Color fundus image:
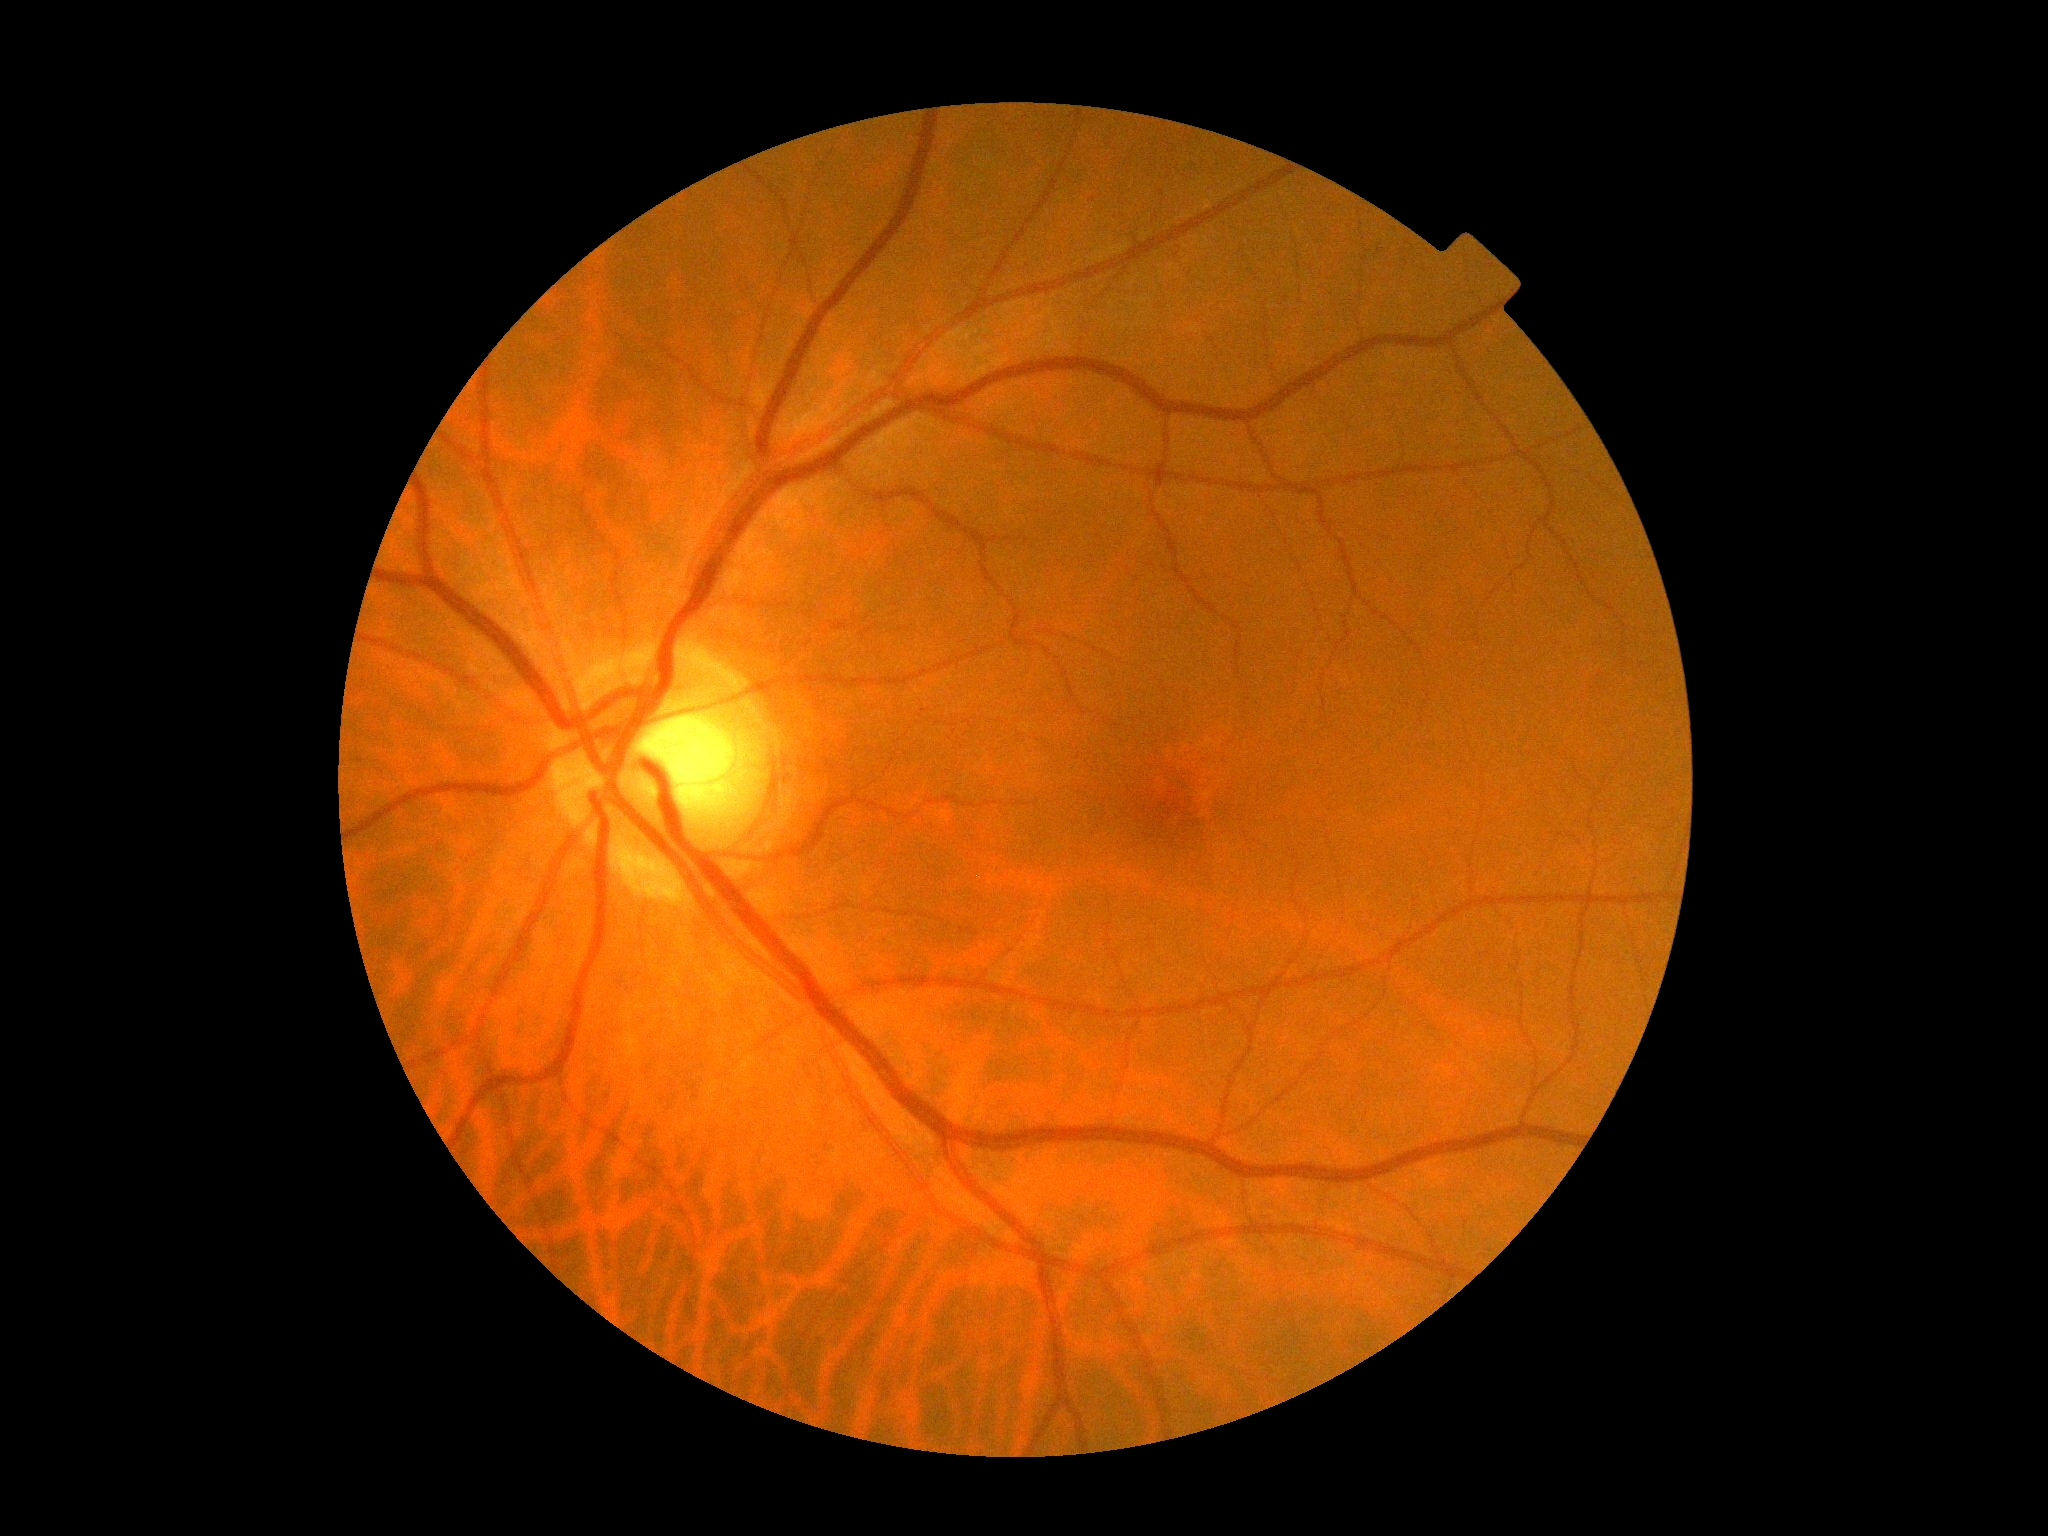
DR grade is 0 (no apparent retinopathy). No diabetic retinal disease findings.